45° FOV · 2352x1568px: 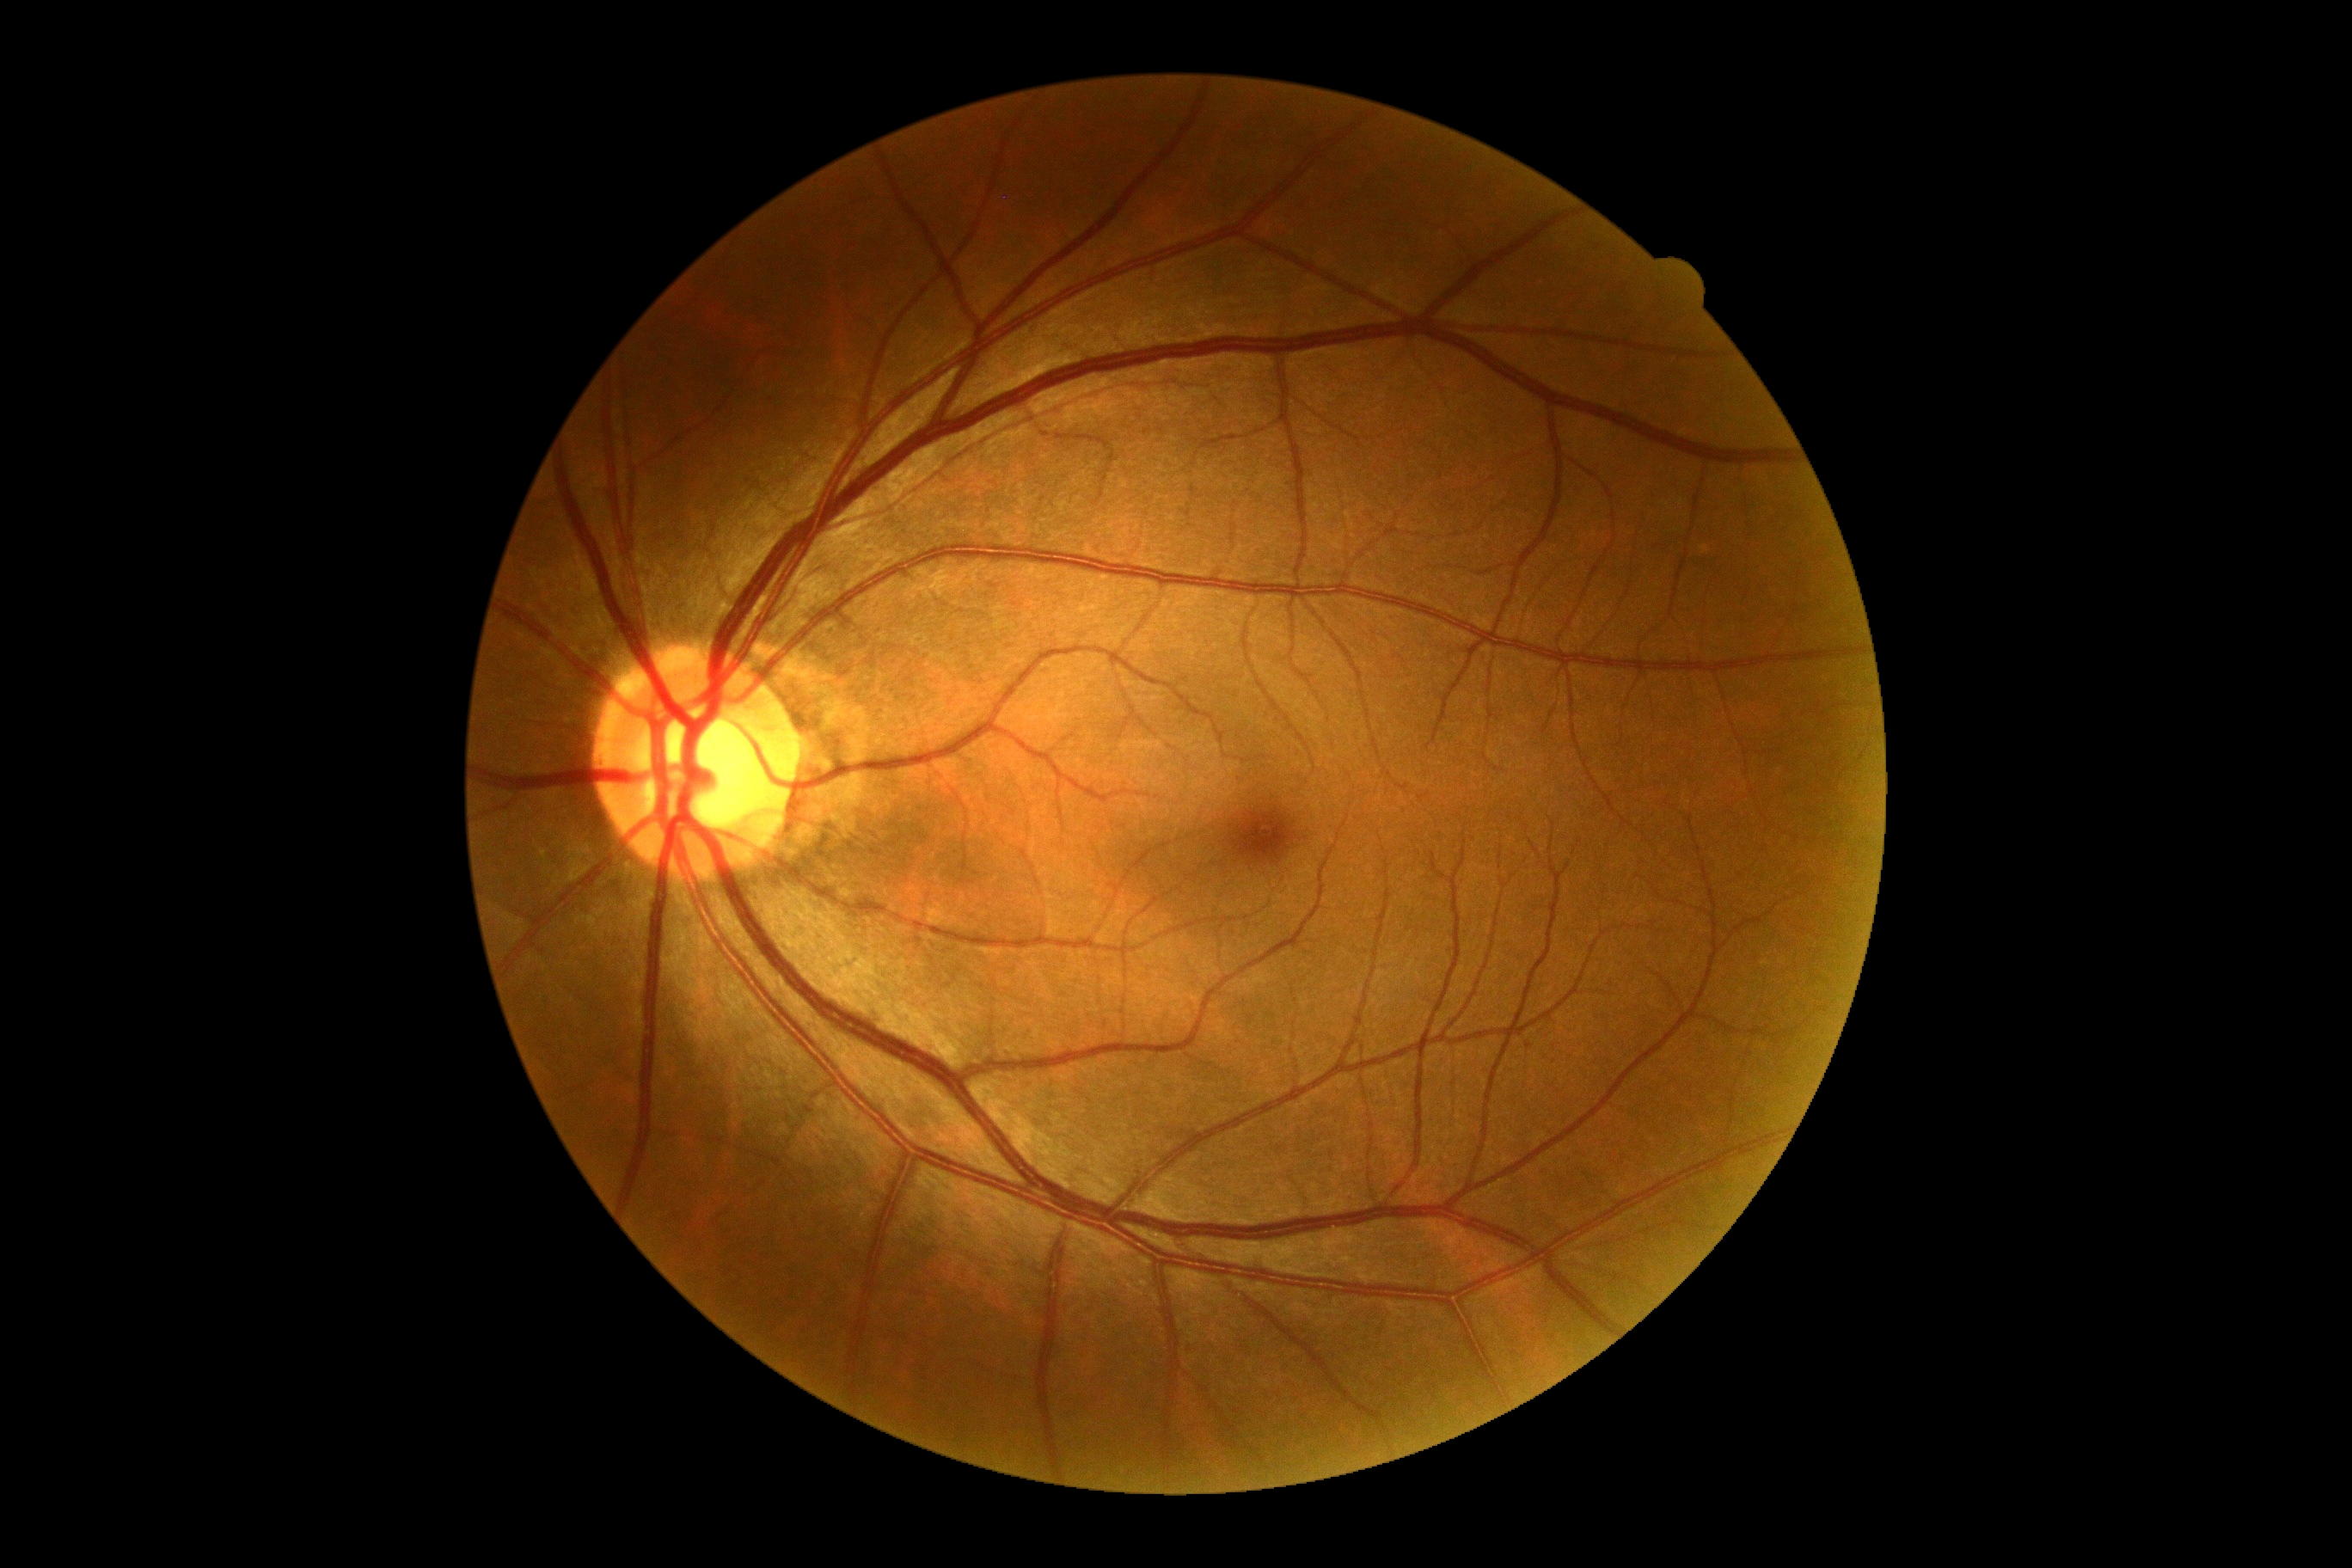

Diabetic retinopathy (DR) is no apparent retinopathy (grade 0).